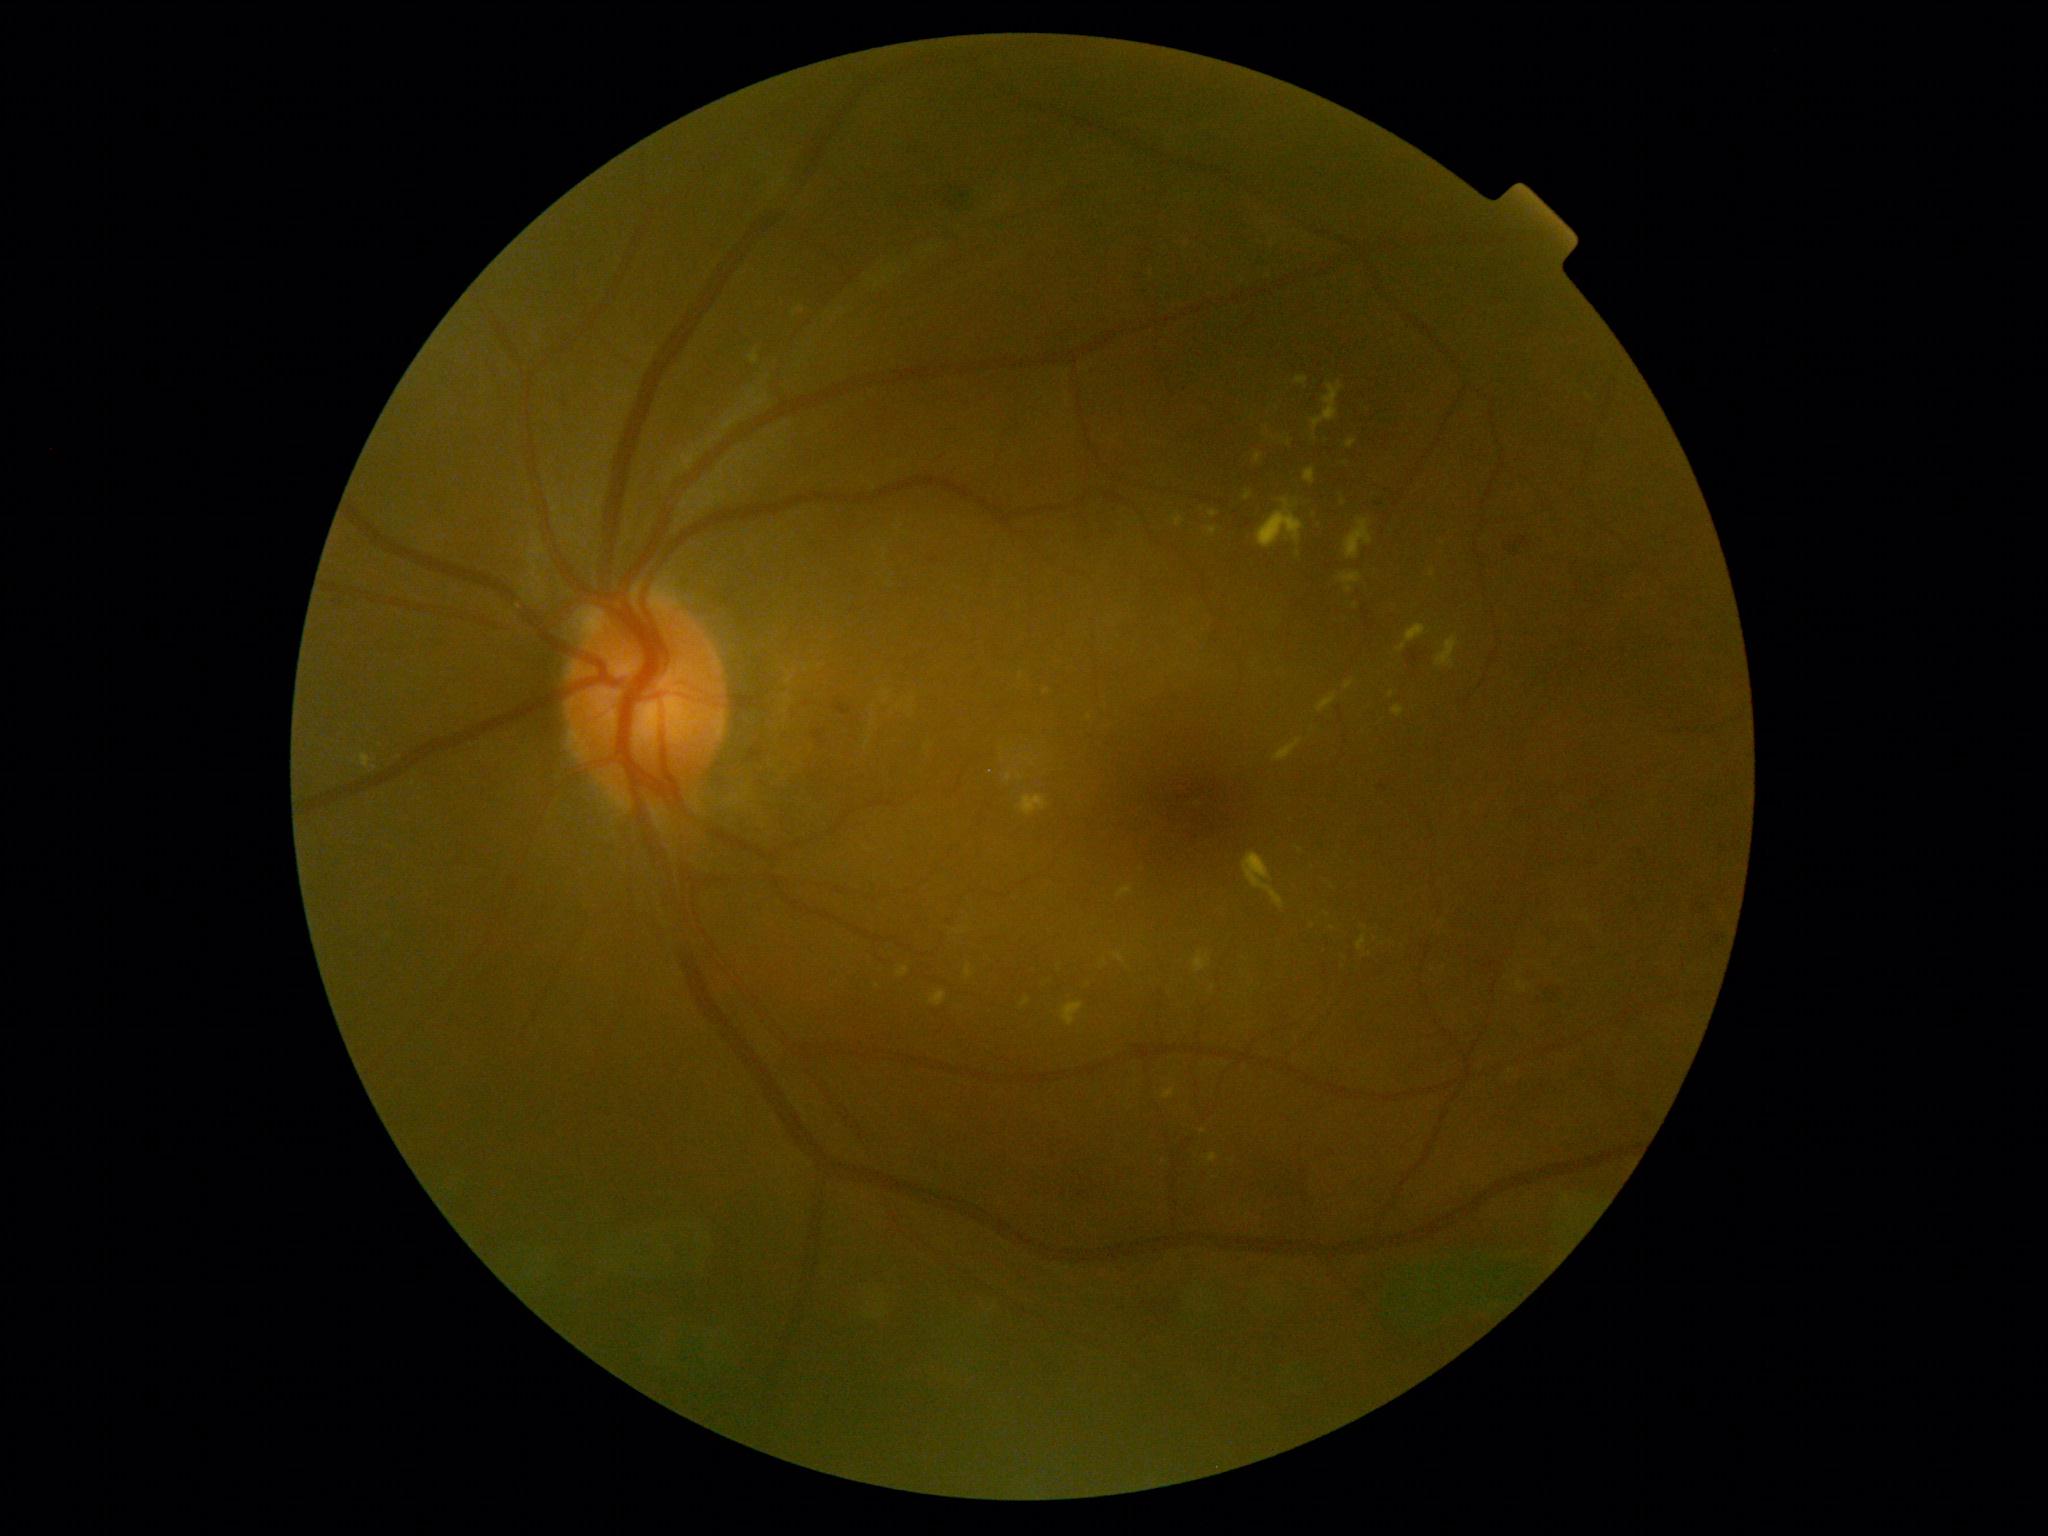

Diabetic retinopathy (DR): grade 2. No soft exudates (SEs) identified. Hard exudates (EXs) include those at 1295 377 1308 385 | 1393 706 1404 717 | 1242 852 1285 909 | 1062 1002 1085 1027 | 1020 998 1032 1007 | 1305 510 1322 548 | 1194 951 1211 972 | 1245 491 1252 500 | 1345 520 1373 560 | 1163 1088 1175 1100 | 1304 468 1315 484 | 749 349 759 365 | 794 308 805 315. Additional small EXs near pt(958, 931) | pt(1433, 573) | pt(1356, 606) | pt(1047, 692) | pt(878, 986) | pt(1313, 926). Hemorrhages (HEs) include those at 1719 833 1735 853 | 834 704 854 716 | 1691 895 1711 914 | 1537 981 1559 1007 | 1406 646 1423 662 | 812 729 827 745 | 930 557 939 564 | 937 183 973 212 | 1503 533 1532 556 | 1363 610 1373 631 | 1715 929 1725 942 | 1377 779 1396 796. No microaneurysms (MAs) identified.